45-degree field of view:
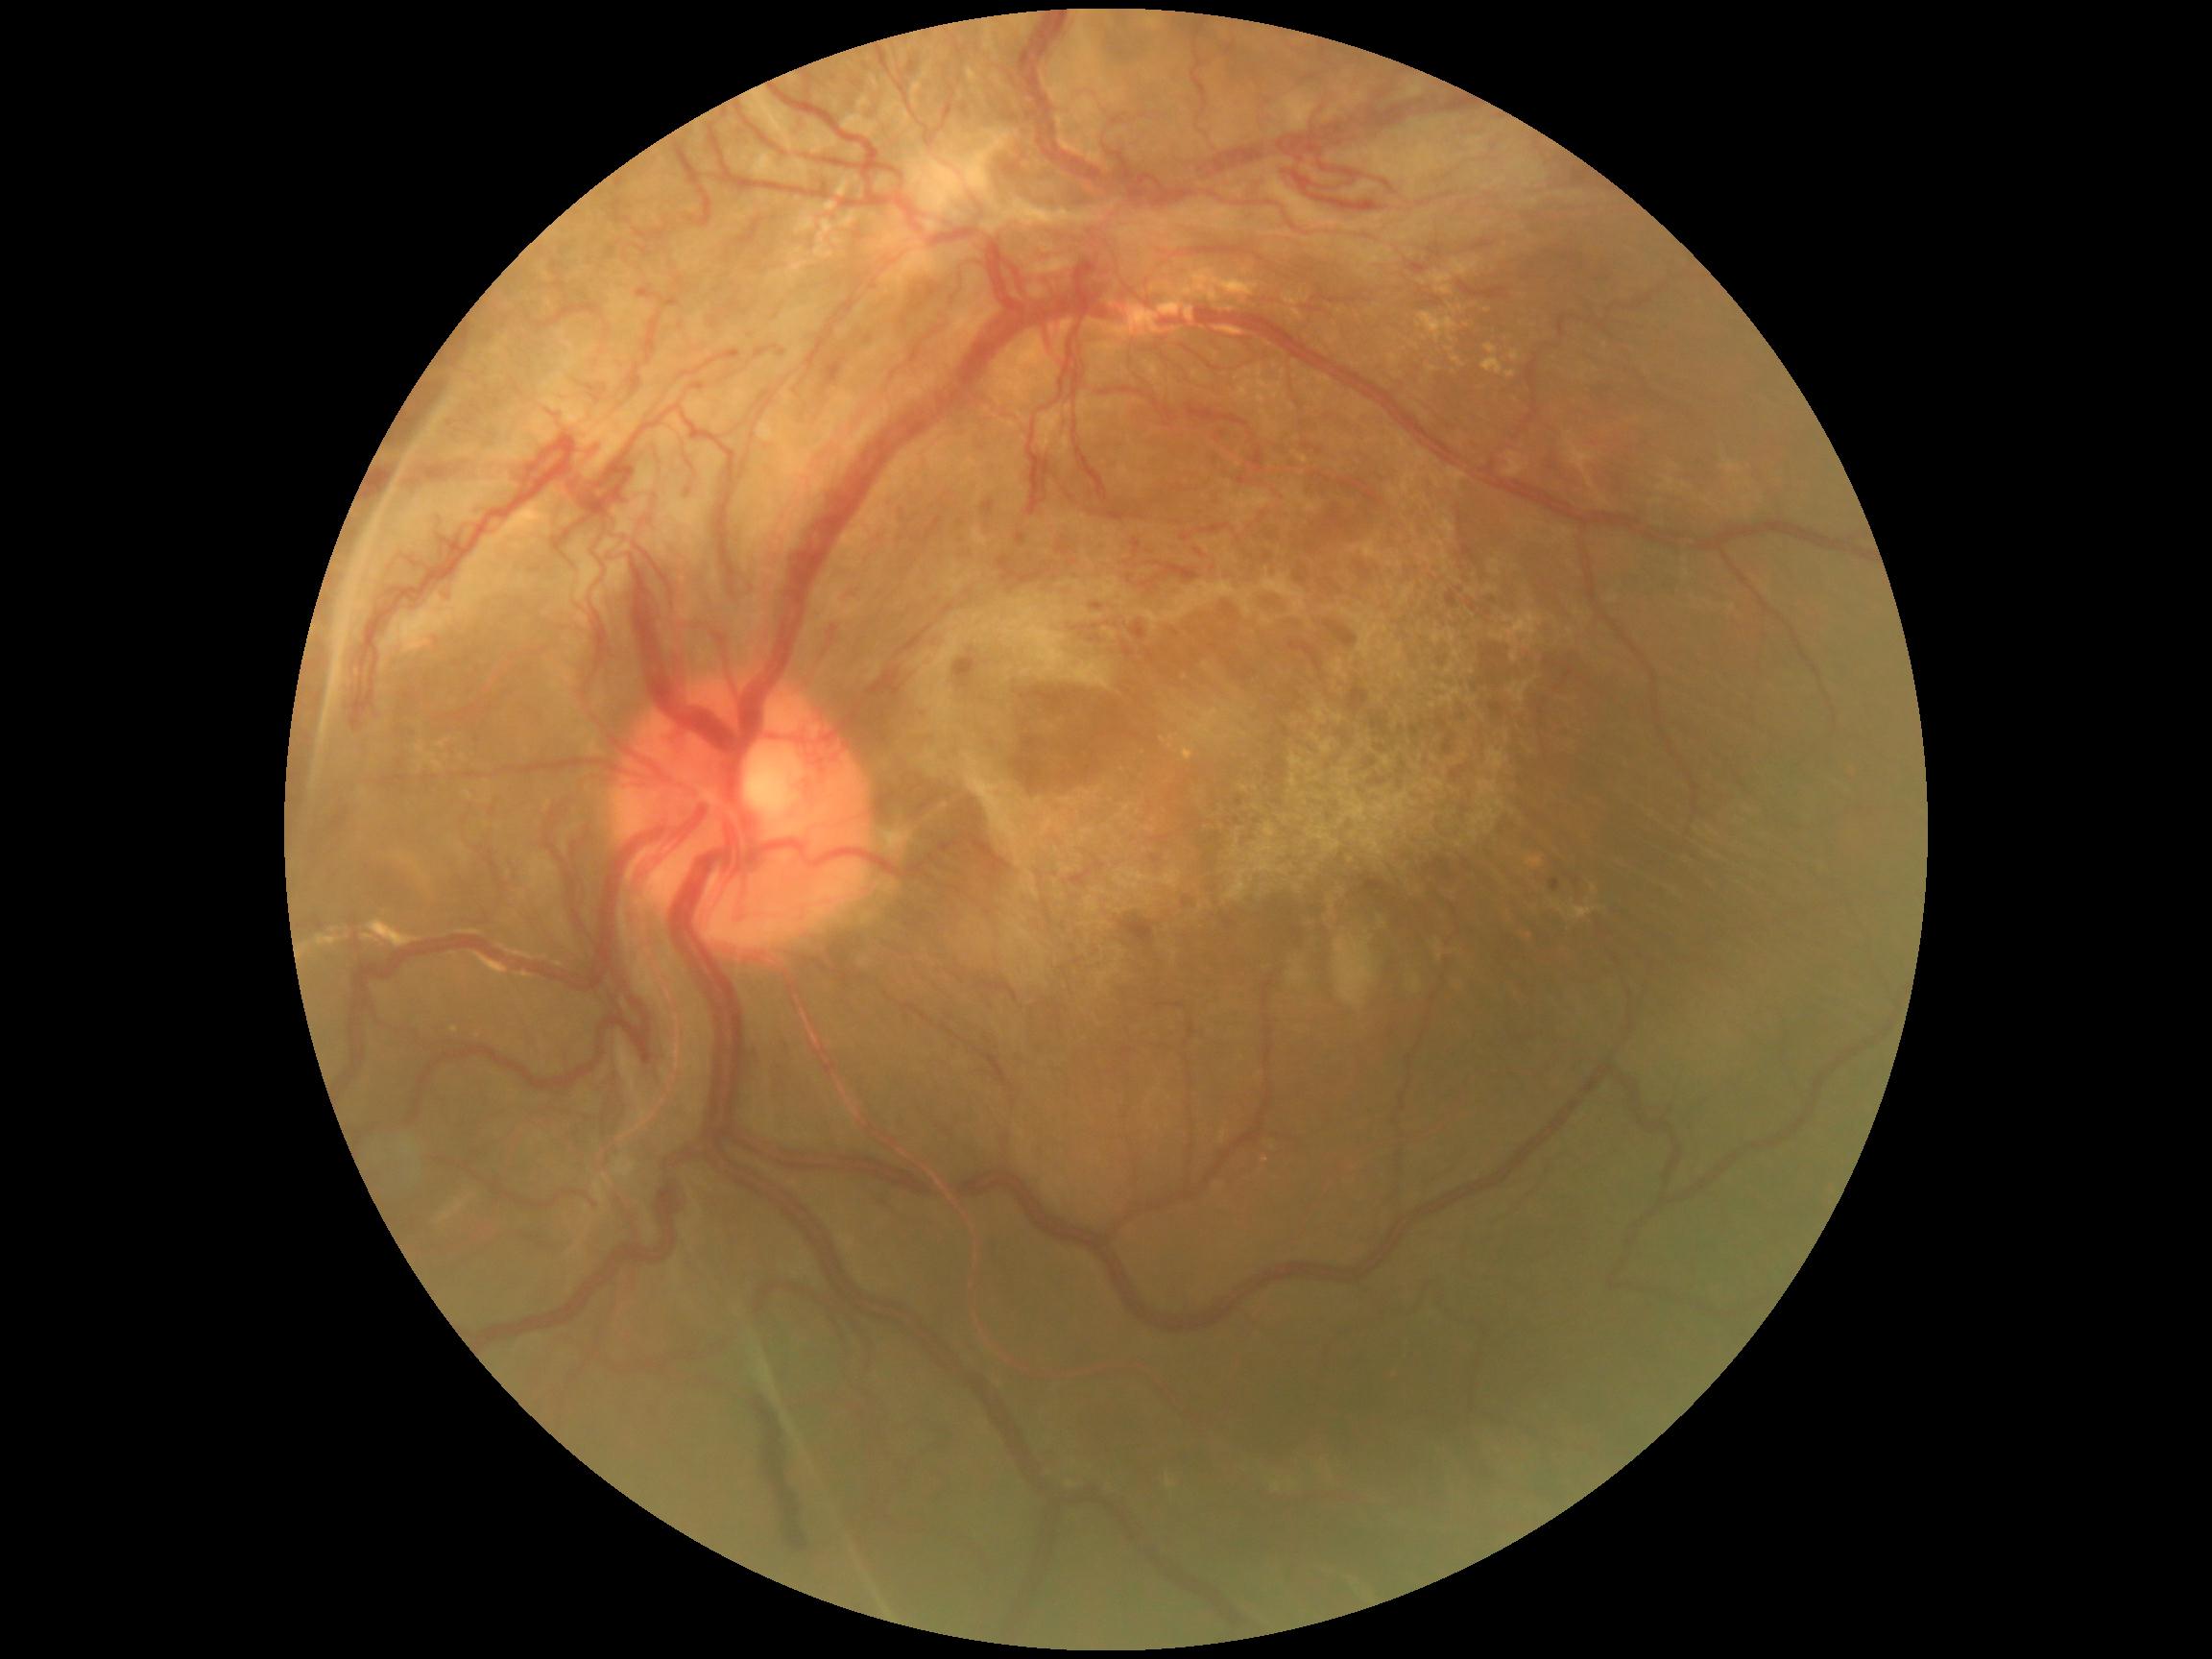
DR stage@grade 4 (PDR), DR class@proliferative diabetic retinopathy.